Mydriatic · fundus photograph cropped around the optic nerve head: 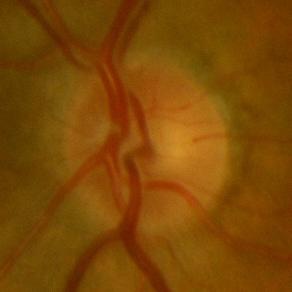

Diagnosis: no glaucoma.